Image size 2048x1536. CFP:
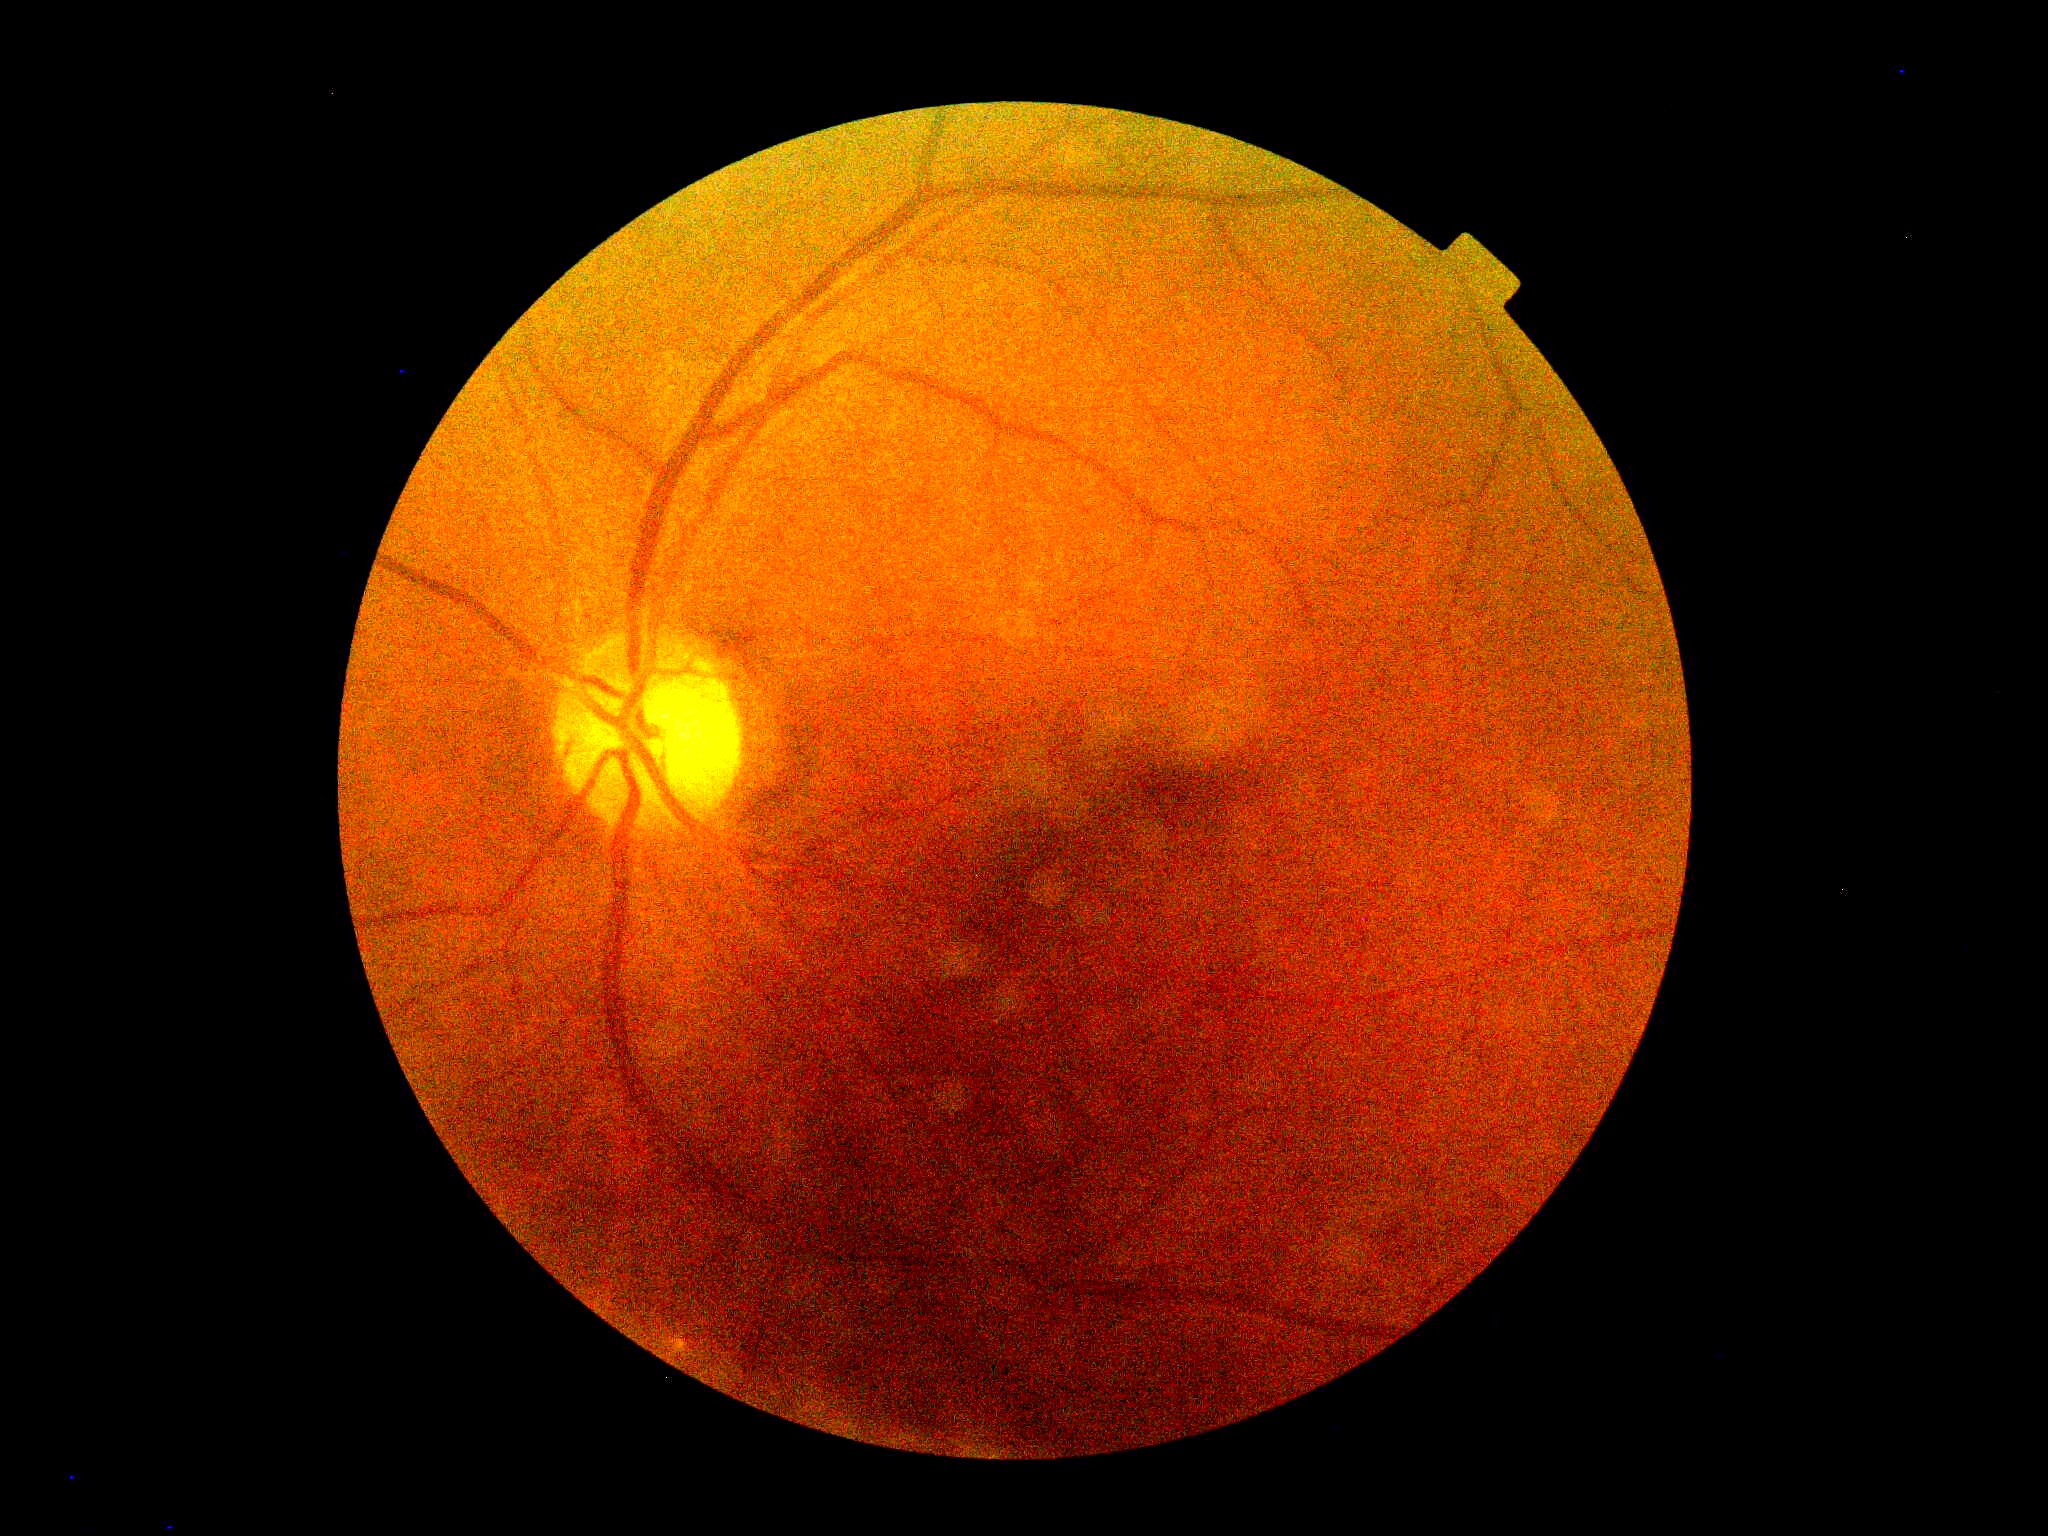

Diabetic retinopathy severity: grade 0. No apparent diabetic retinopathy.